NIDEK AFC-230, CFP: 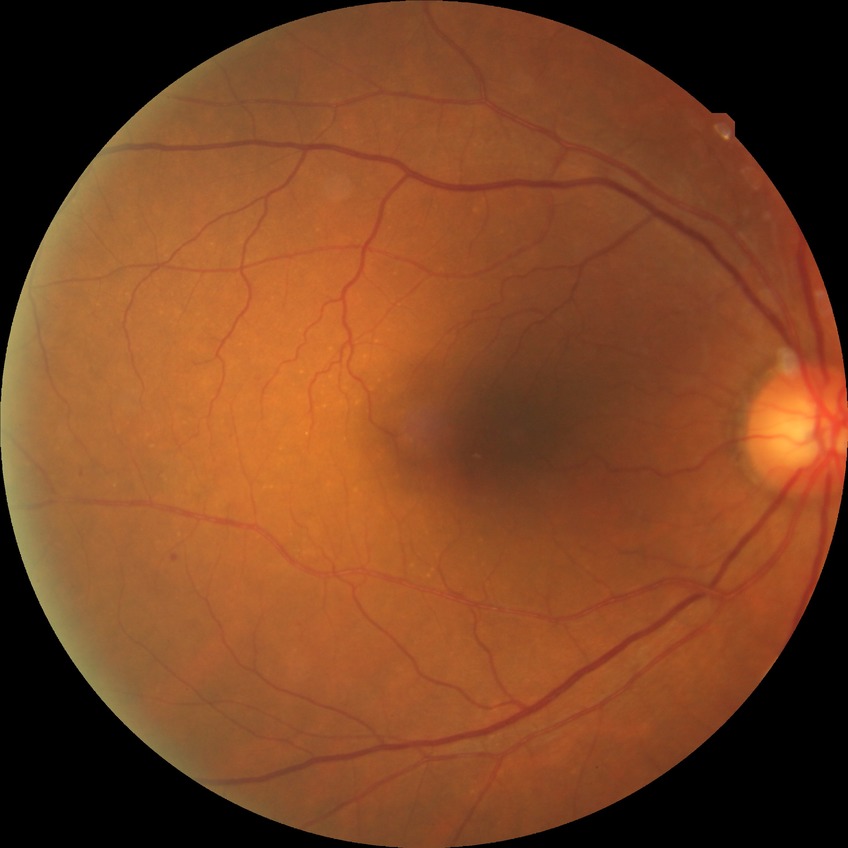

Diabetic retinopathy (DR): simple diabetic retinopathy (SDR). The retinopathy is classified as non-proliferative diabetic retinopathy.